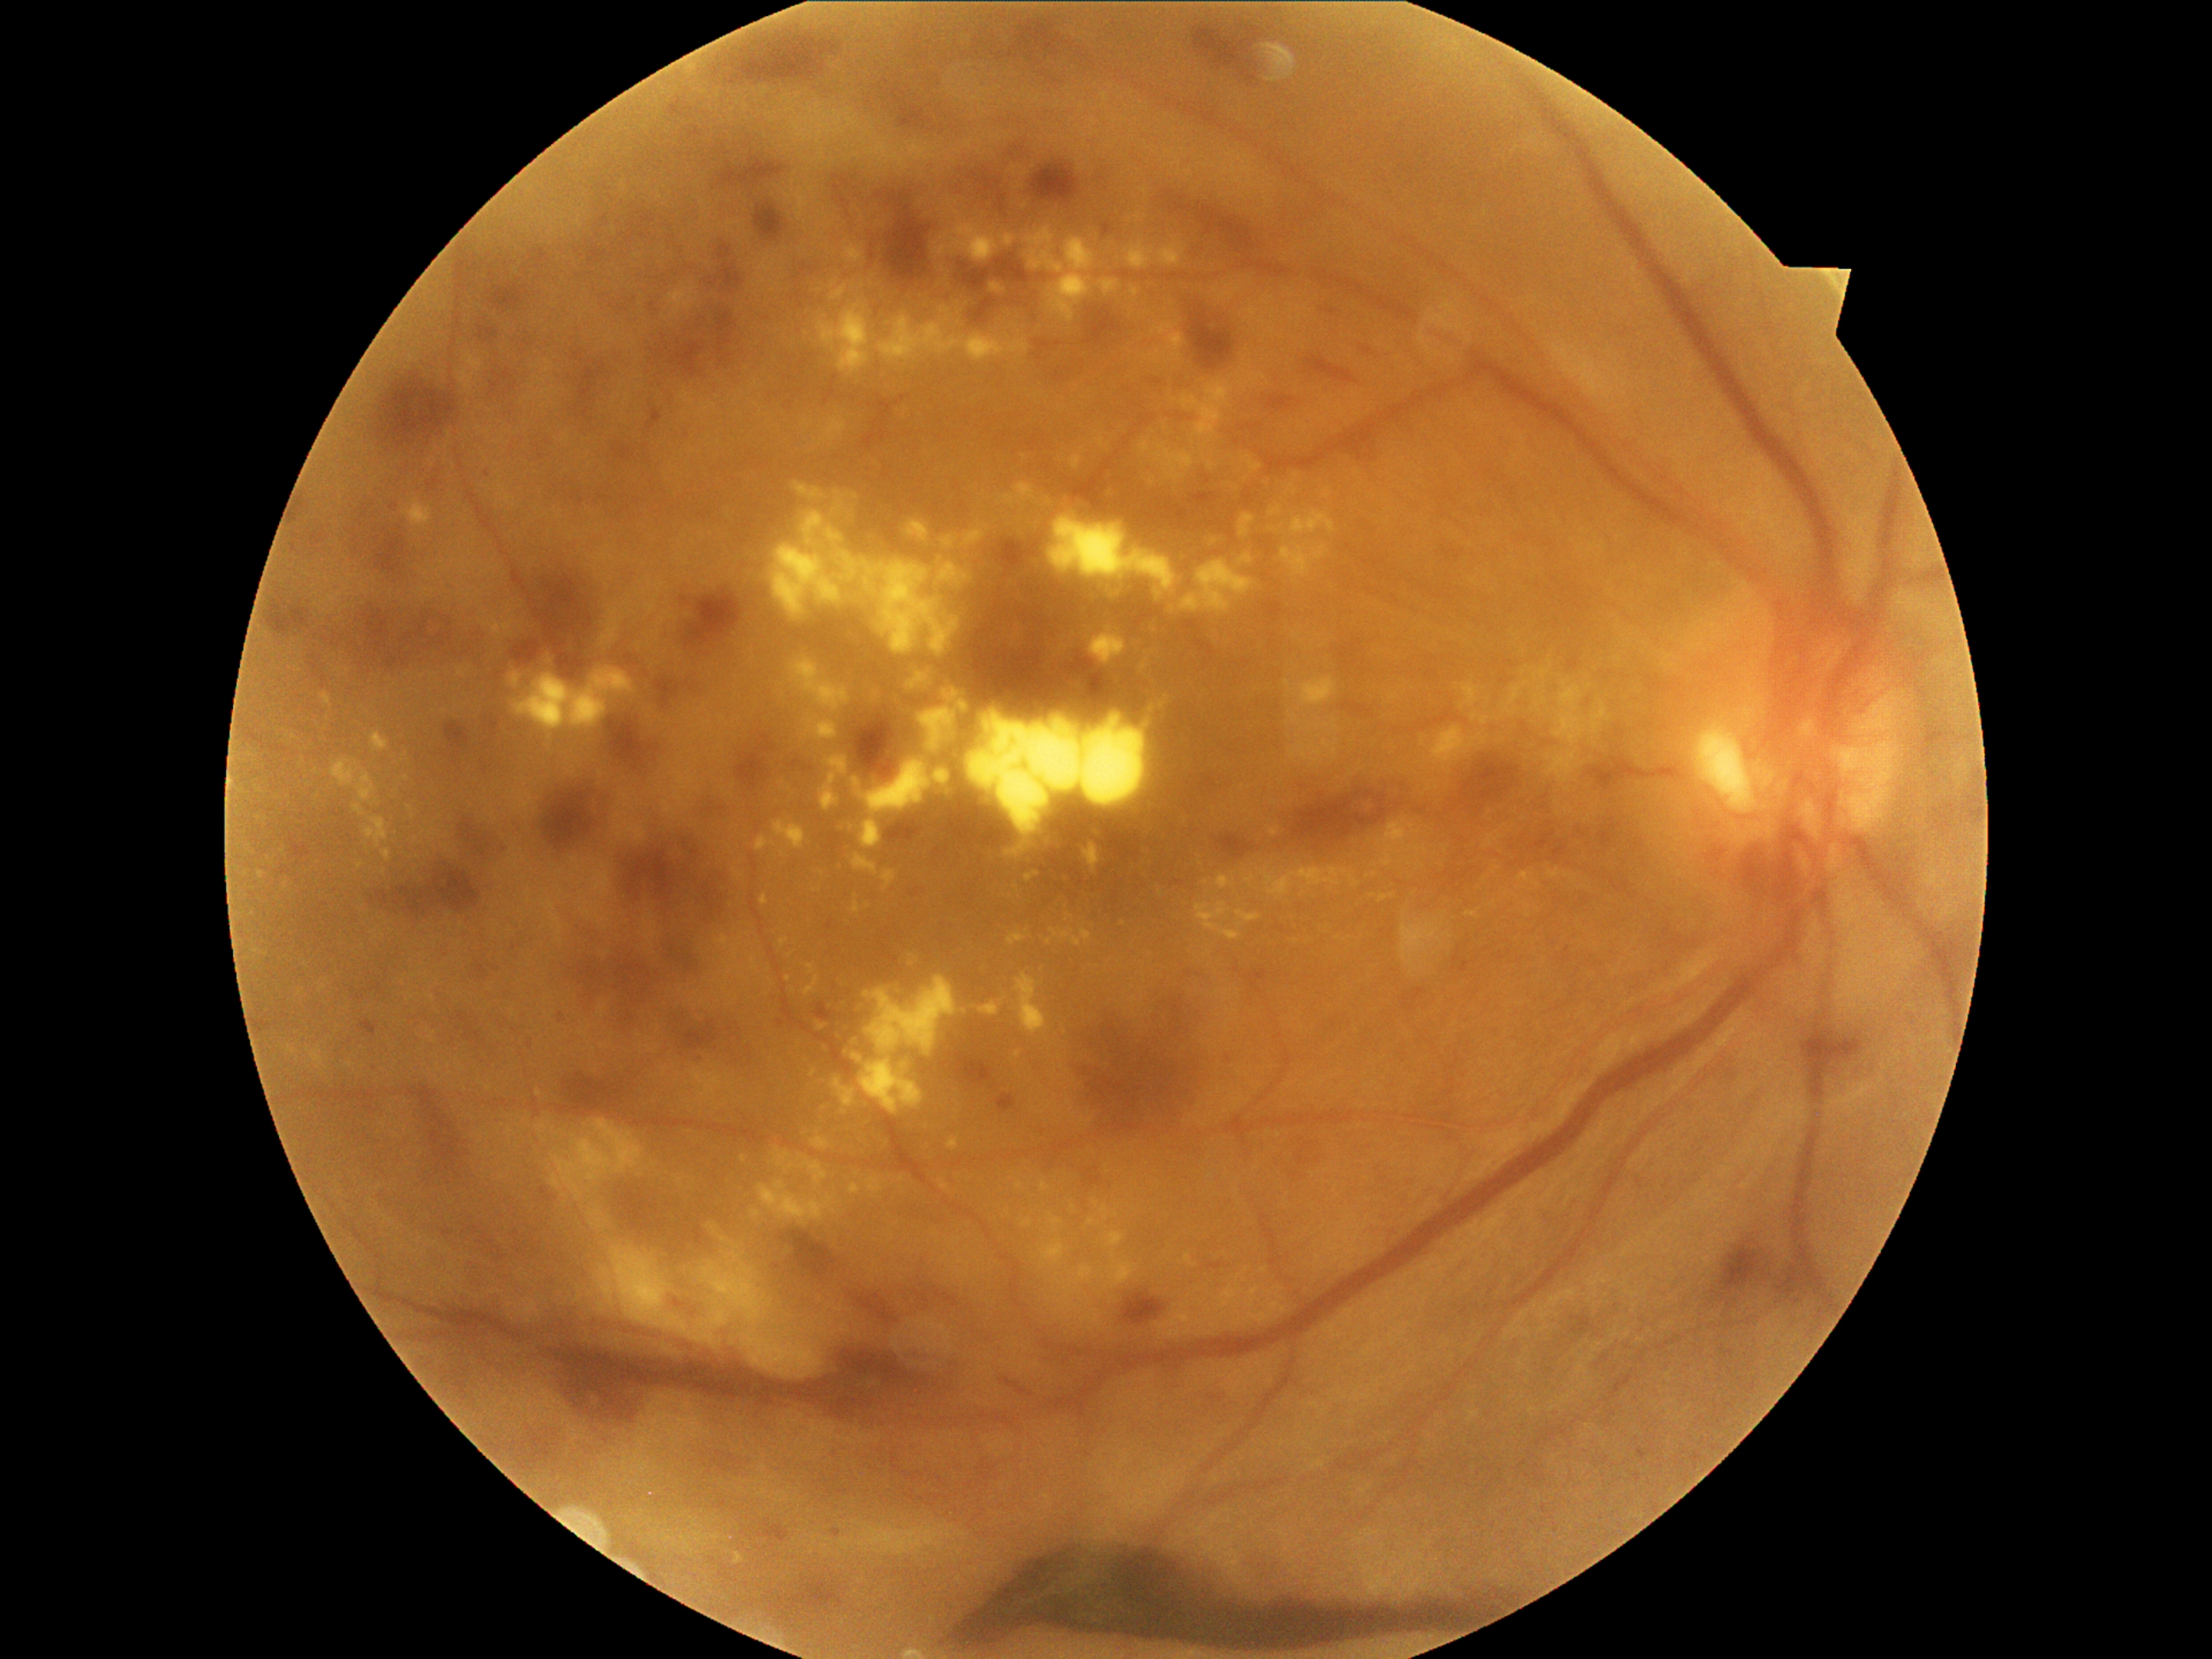 DR: PDR (grade 4)
A subset of detected lesions:
EXs (subset) = rect(853, 902, 861, 916) | rect(714, 934, 759, 984) | rect(1237, 554, 1254, 566) | rect(1040, 1238, 1068, 1266) | rect(1237, 909, 1260, 929) | rect(854, 779, 861, 788) | rect(779, 940, 789, 948) | rect(1518, 873, 1540, 888) | rect(940, 1180, 952, 1192) | rect(1155, 443, 1196, 474) | rect(878, 308, 1030, 363) | rect(1547, 868, 1569, 880)
Smaller EXs around <pt>780,685</pt> | <pt>1202,1322</pt> | <pt>913,956</pt> | <pt>1410,827</pt> | <pt>1373,895</pt> | <pt>1559,814</pt> | <pt>1043,1267</pt> | <pt>768,971</pt>